Color fundus photograph — 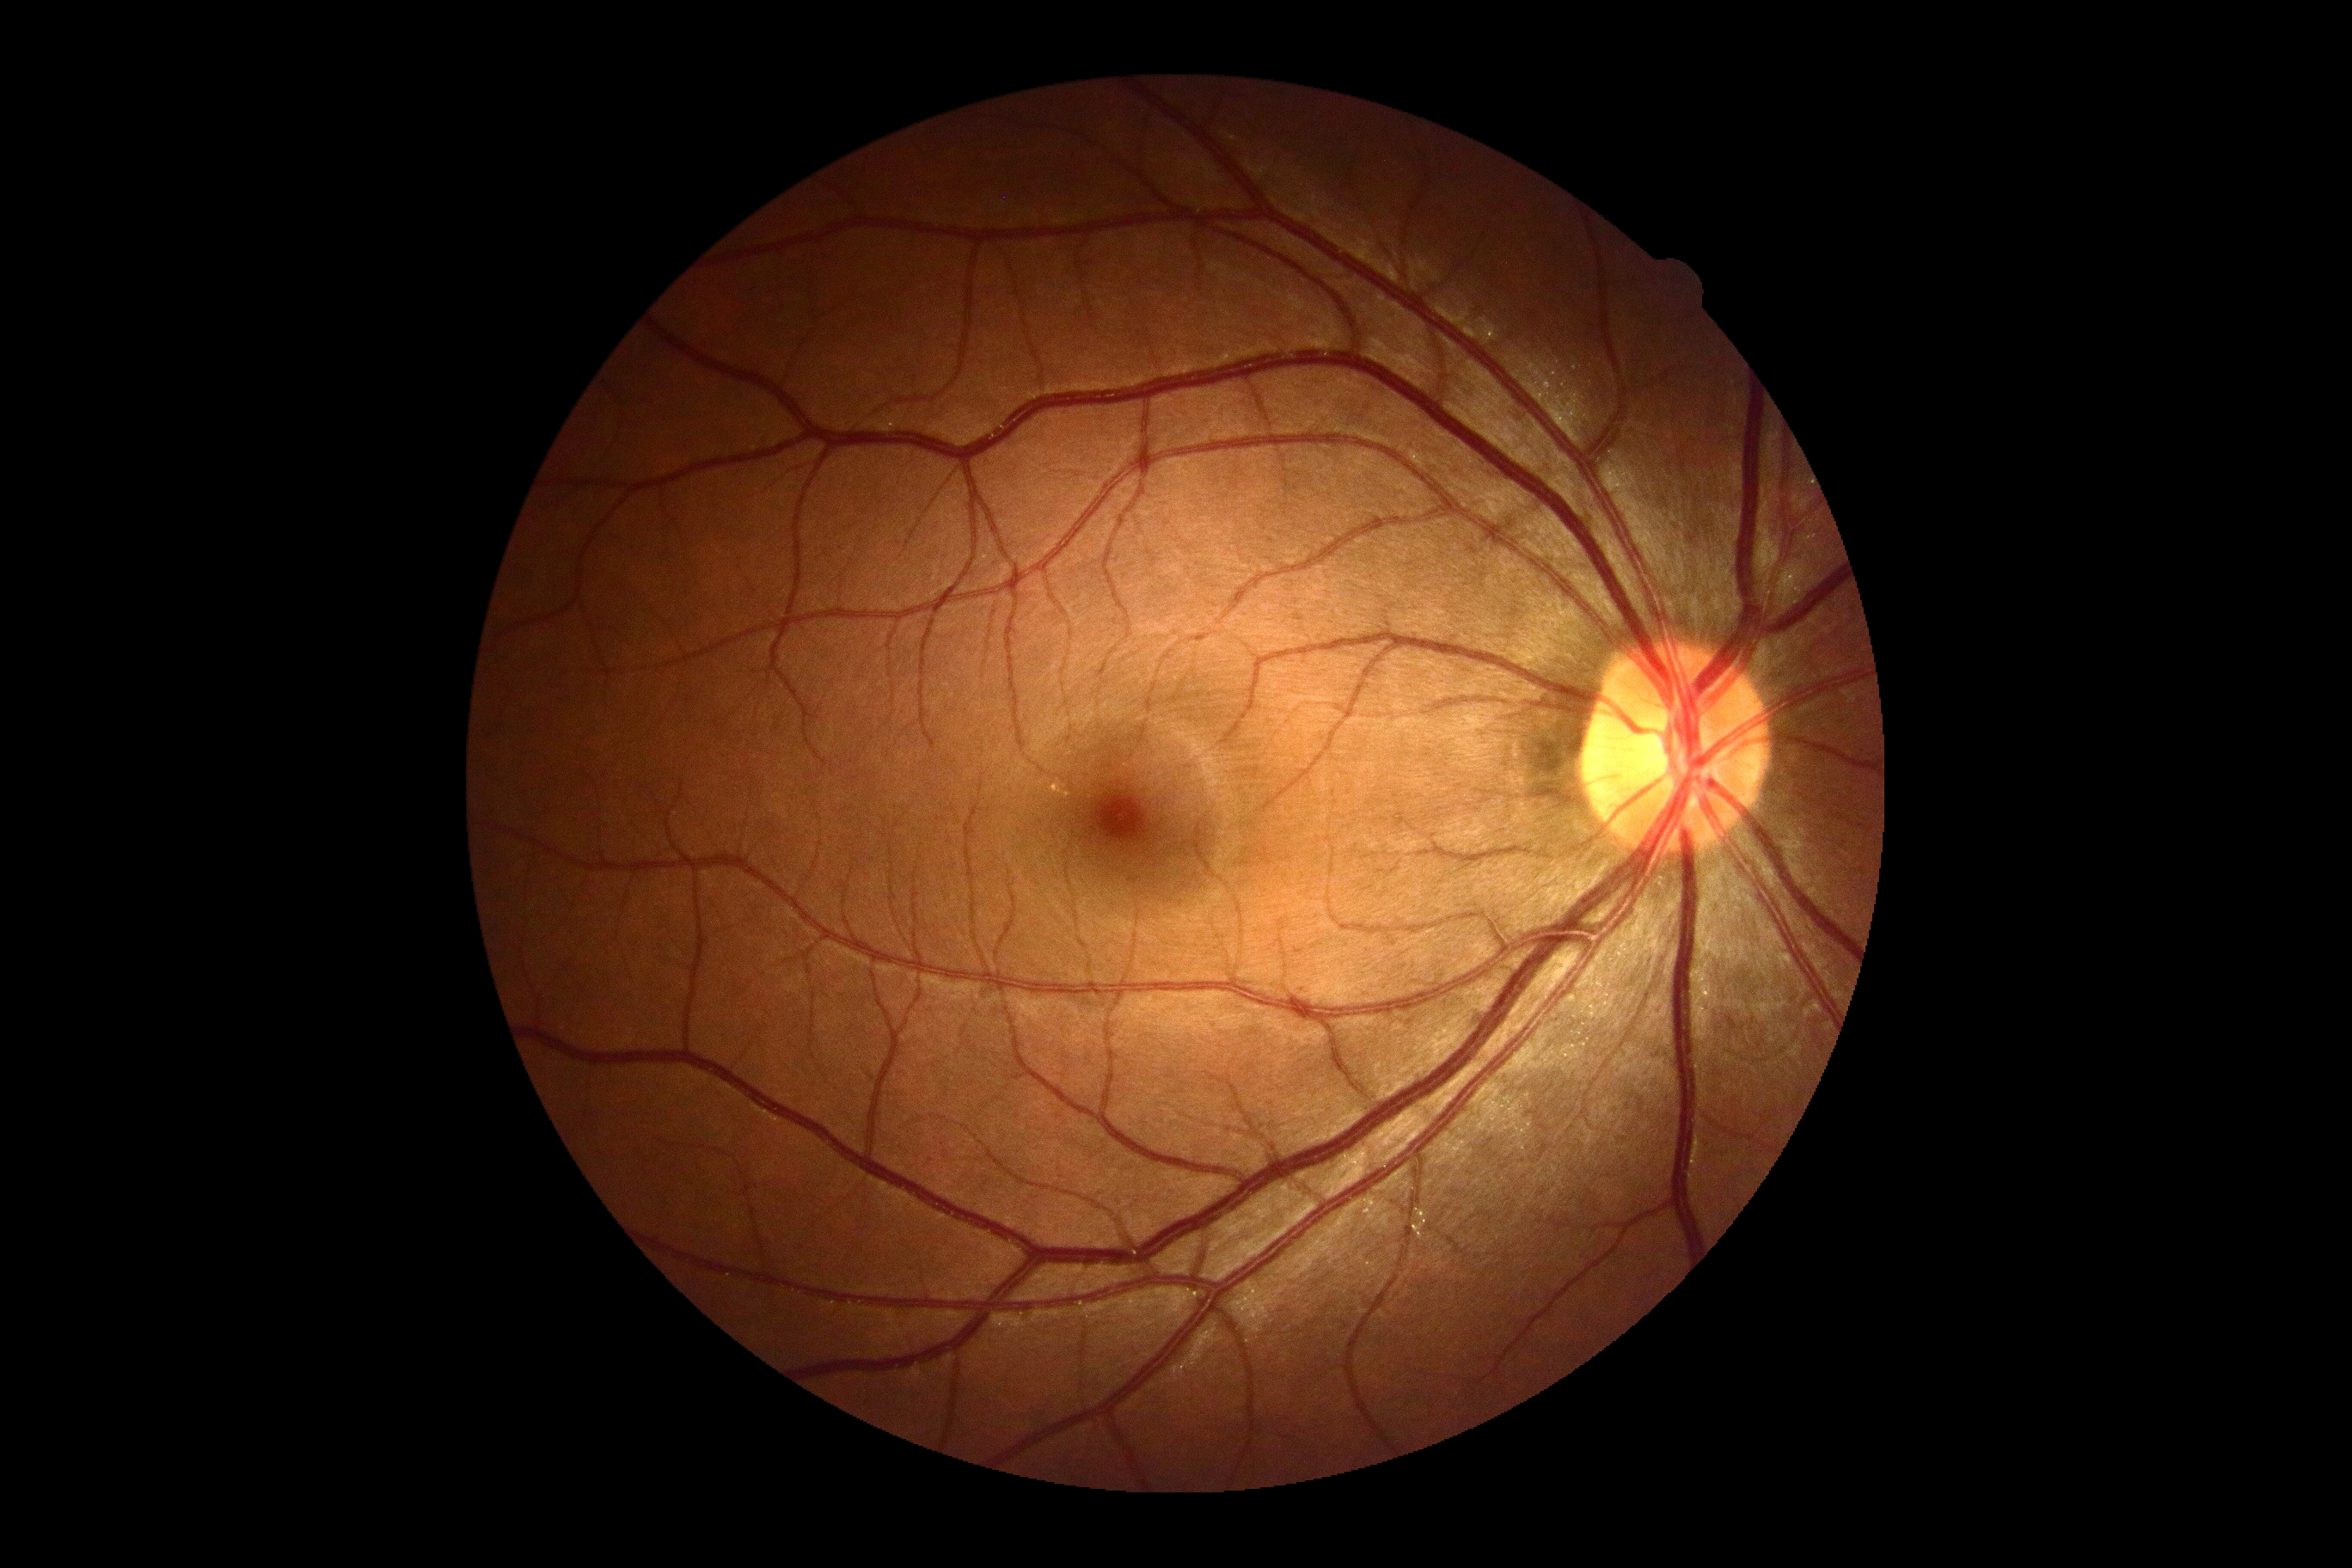

DR impression=no DR findings; DR=grade 0 (no apparent retinopathy).